45° field of view — 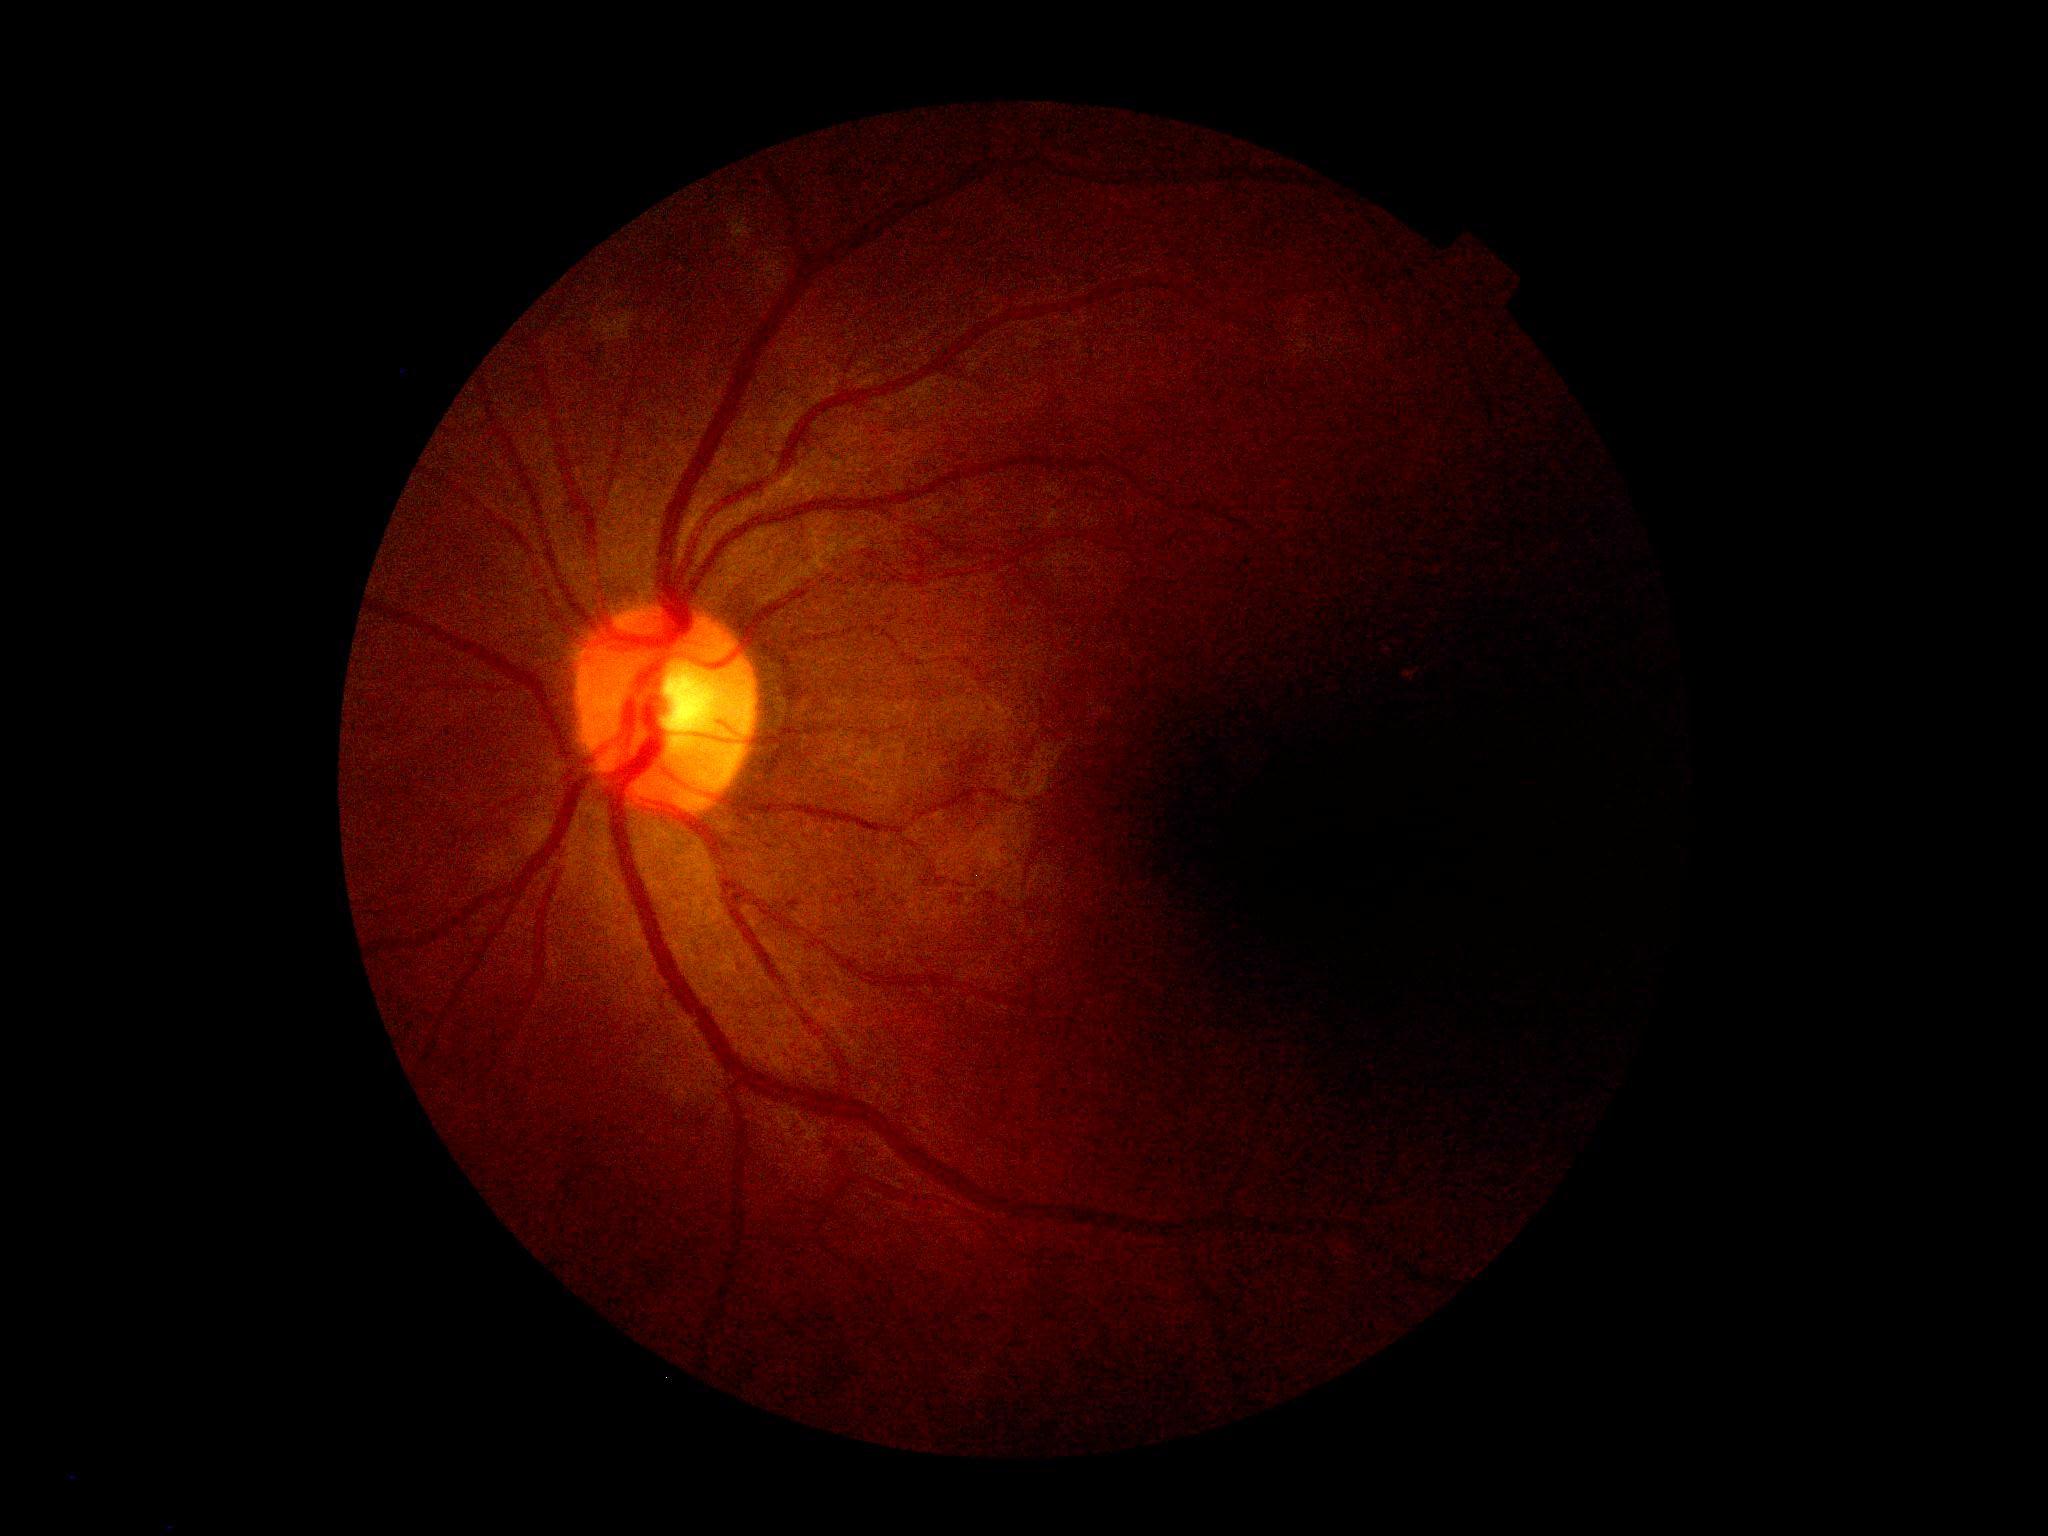

Findings:
• diabetic retinopathy (DR) — no apparent retinopathy (grade 0)